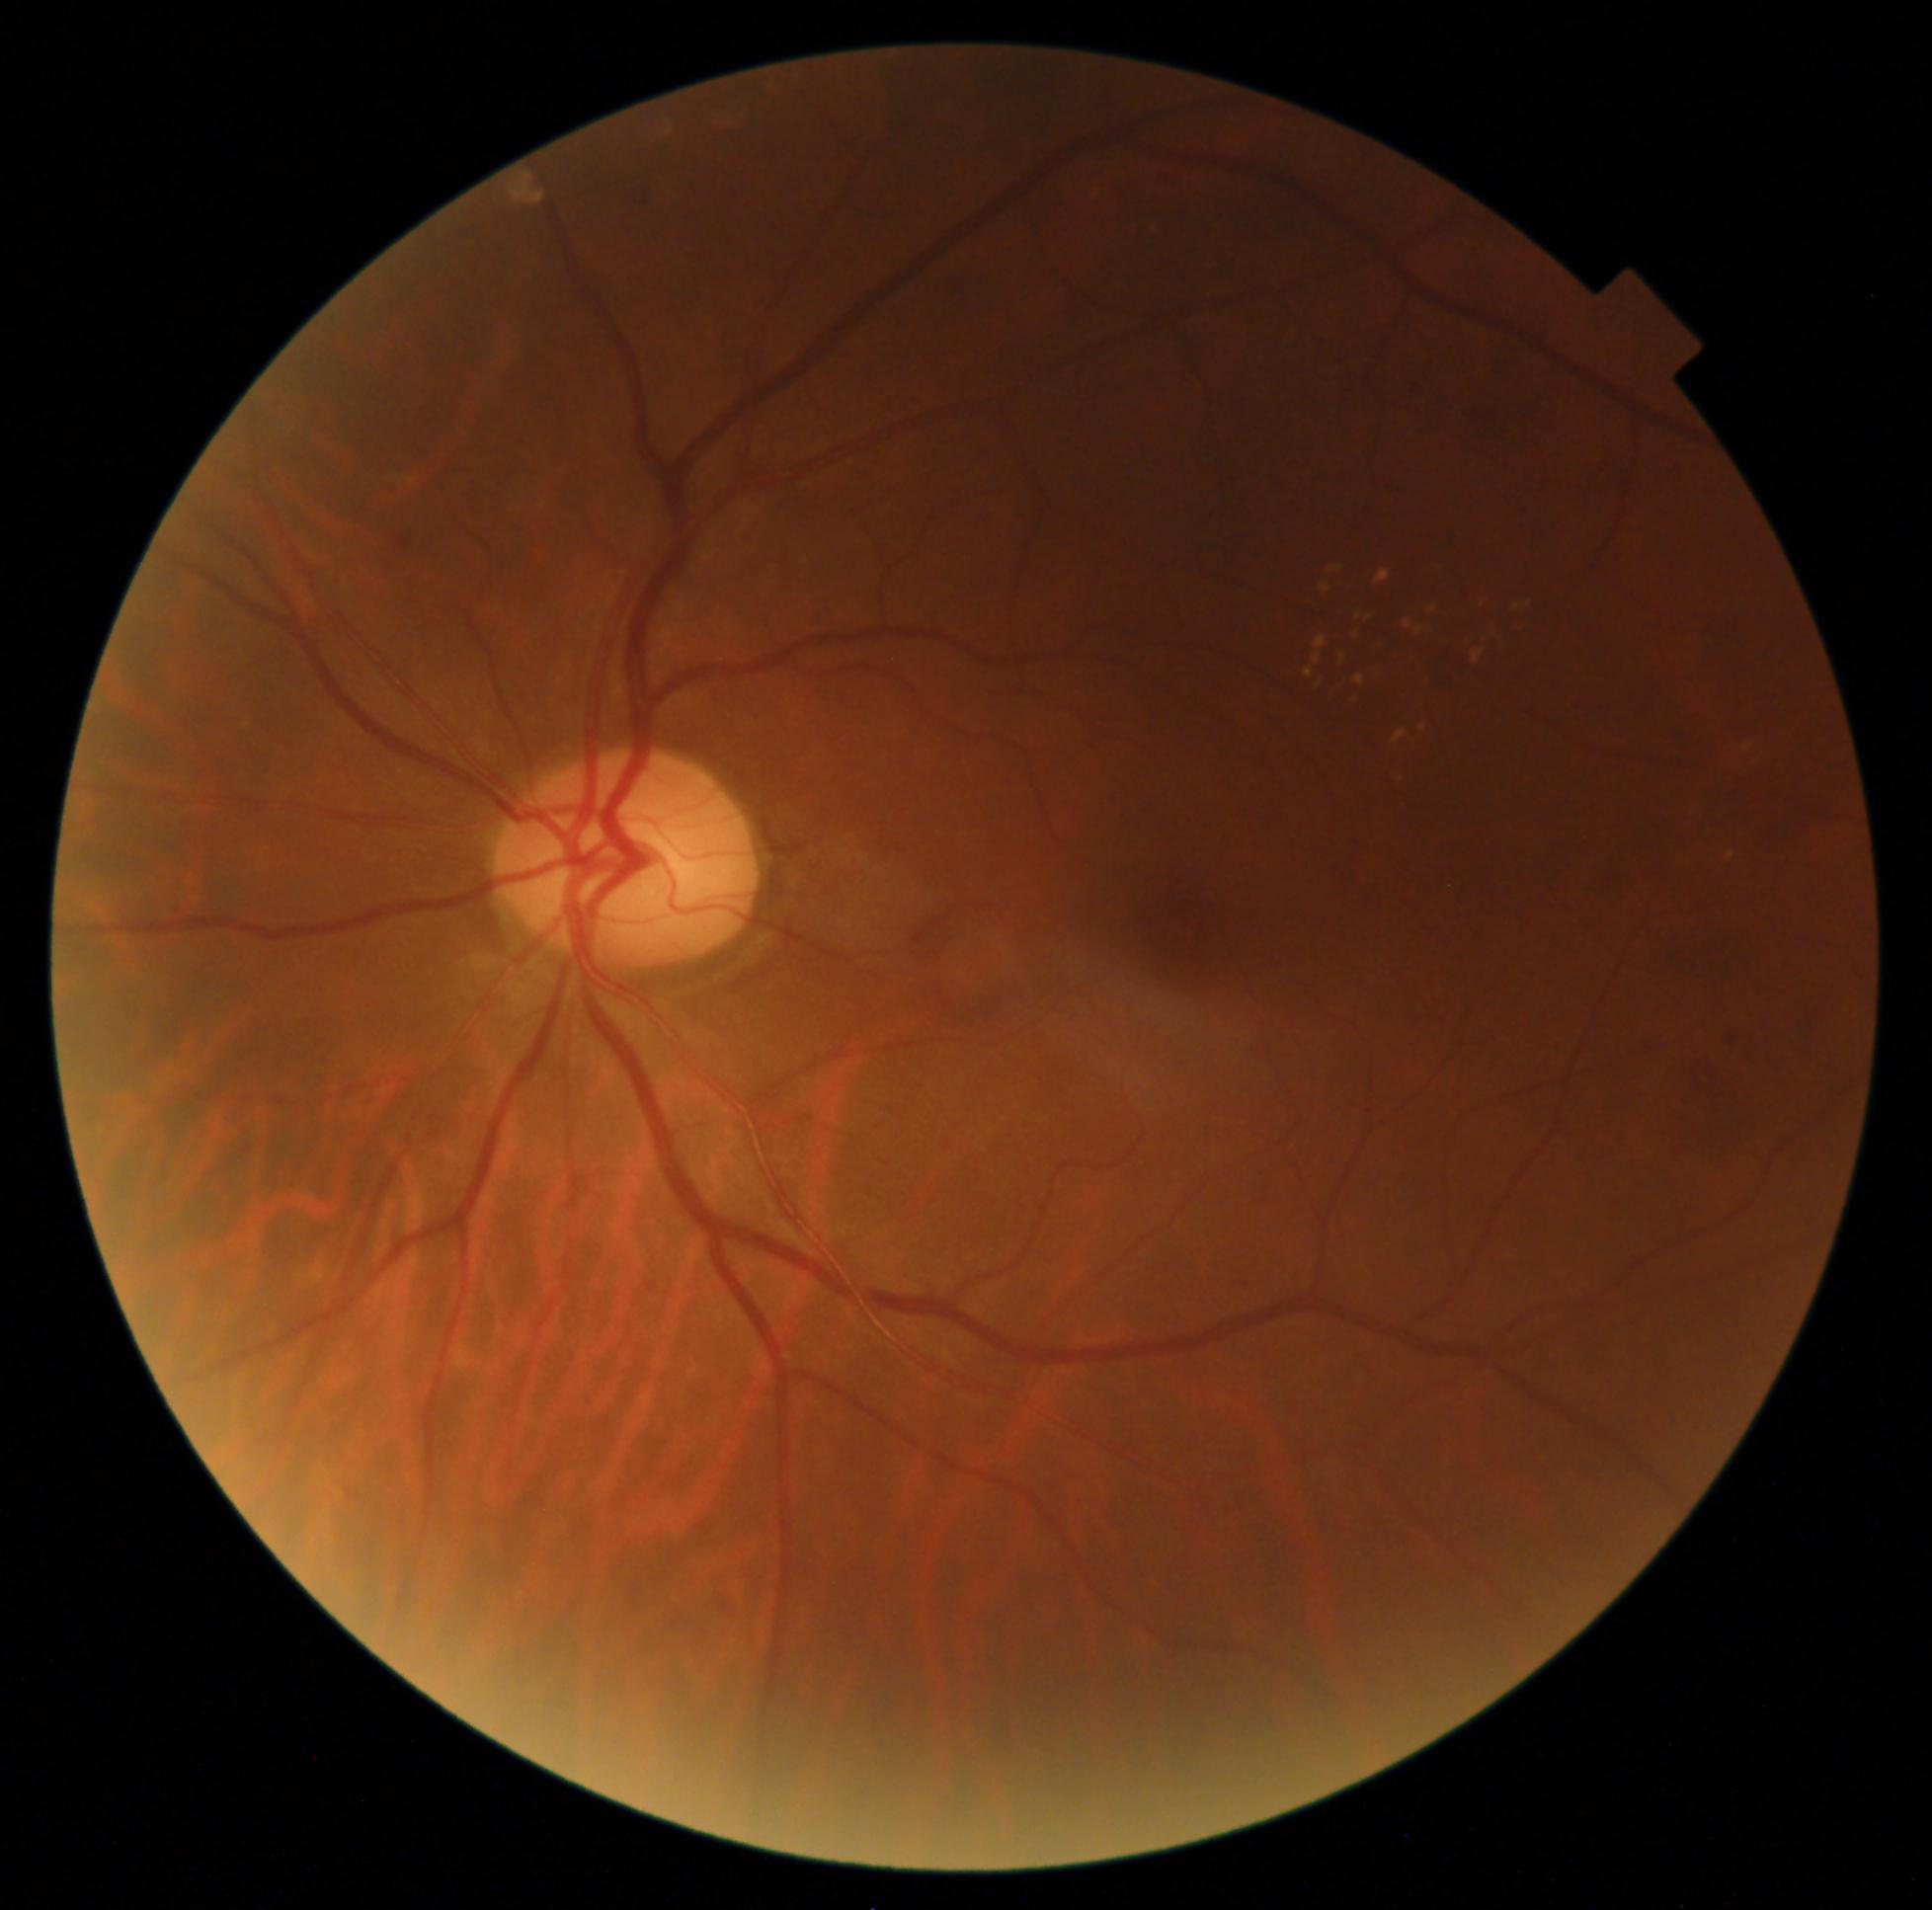
DR class: non-proliferative diabetic retinopathy.
DR severity: 2/4.